Acquired with a Nidek AFC-330, non-mydriatic fundus camera:
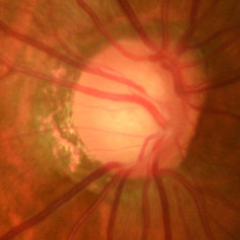

Demonstrates early glaucomatous changes.